Camera: NIDEK AFC-230. Posterior pole photograph. 848x848px. 45-degree field of view
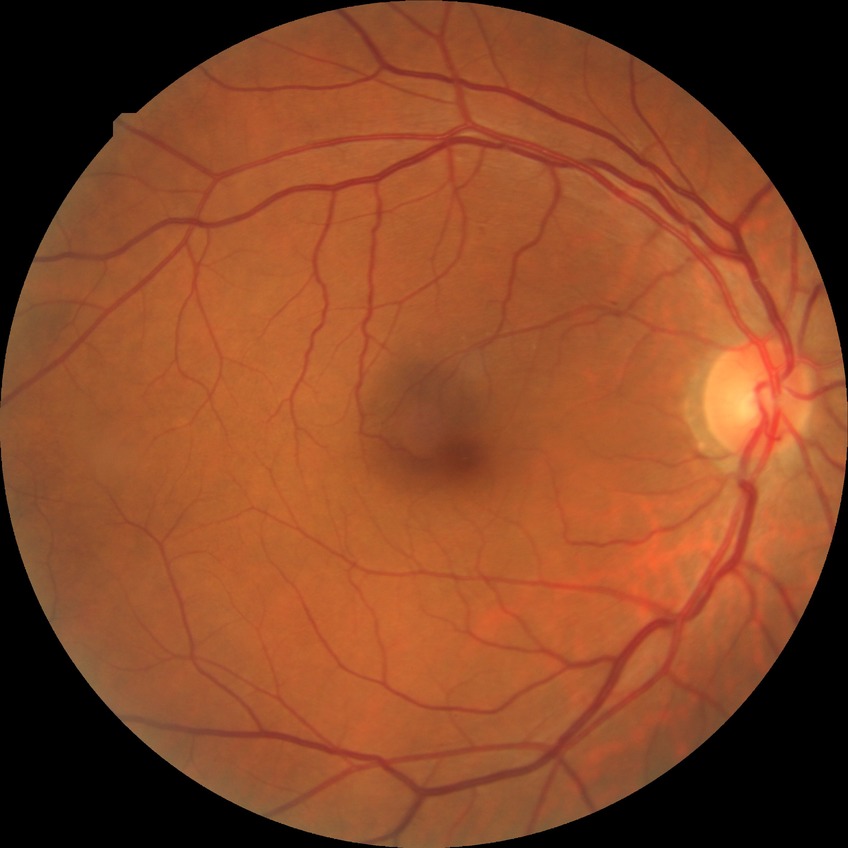

Diabetic retinopathy (DR): no diabetic retinopathy (NDR).